Nidek AFC-330, captured without pupil dilation, color fundus photograph — 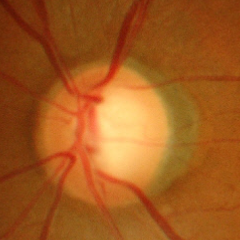

Findings consistent with advanced glaucomatous optic neuropathy. Defined as near-total cupping of the optic nerve head, with or without severe visual field loss within the central 10 degrees of fixation.